No pharmacologic dilation
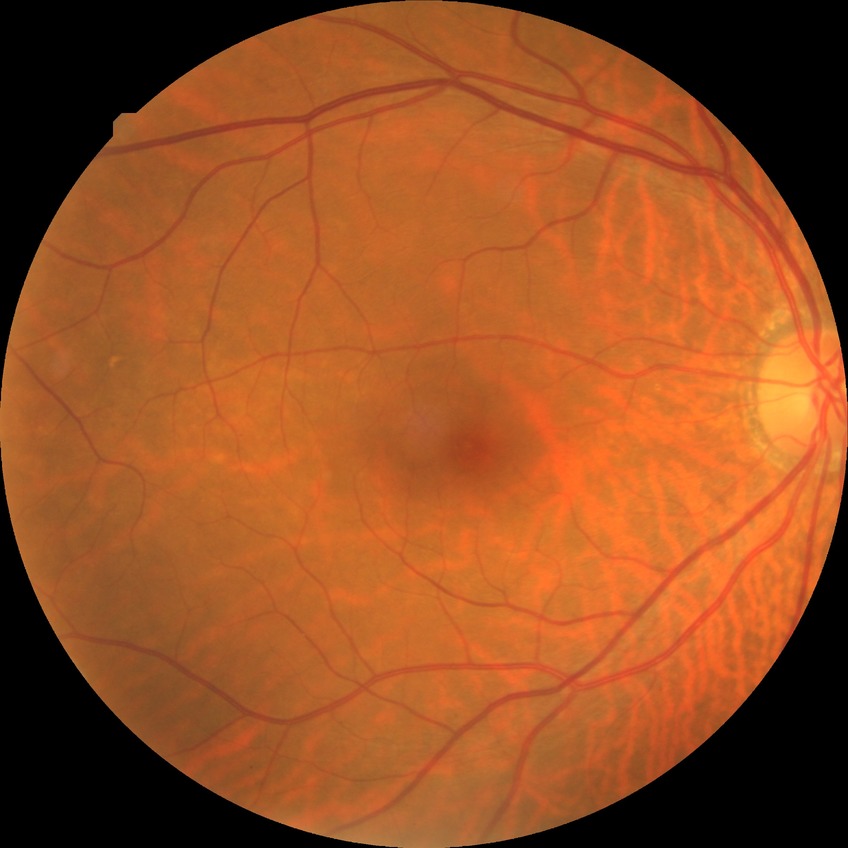 Diabetic retinopathy (DR) is NDR (no diabetic retinopathy).